Infant wide-field retinal image: 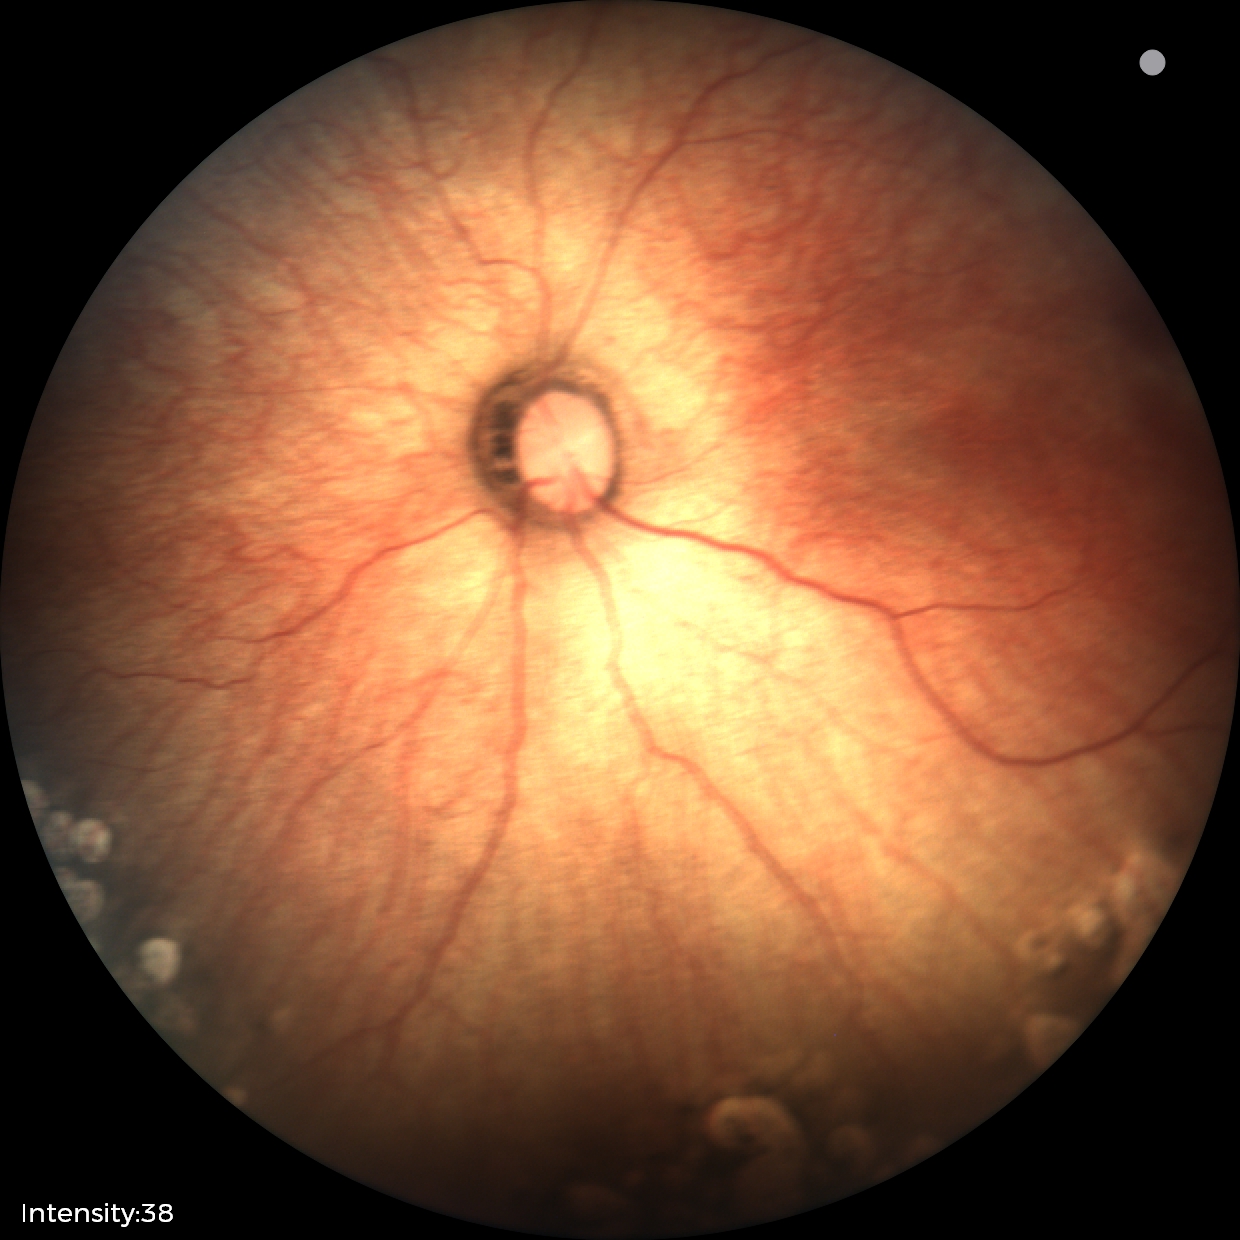 No plus disease.
Screening examination consistent with status post ROP — retinal appearance after treated retinopathy of prematurity.